Captured with pupil dilation, acquired with a Topcon TRC, fundus photograph cropped around the optic nerve head.
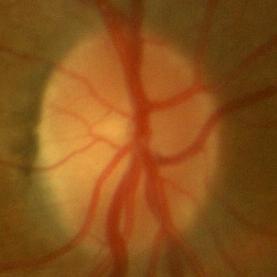 There is evidence of no glaucomatous findings.